Pediatric retinal photograph (wide-field): 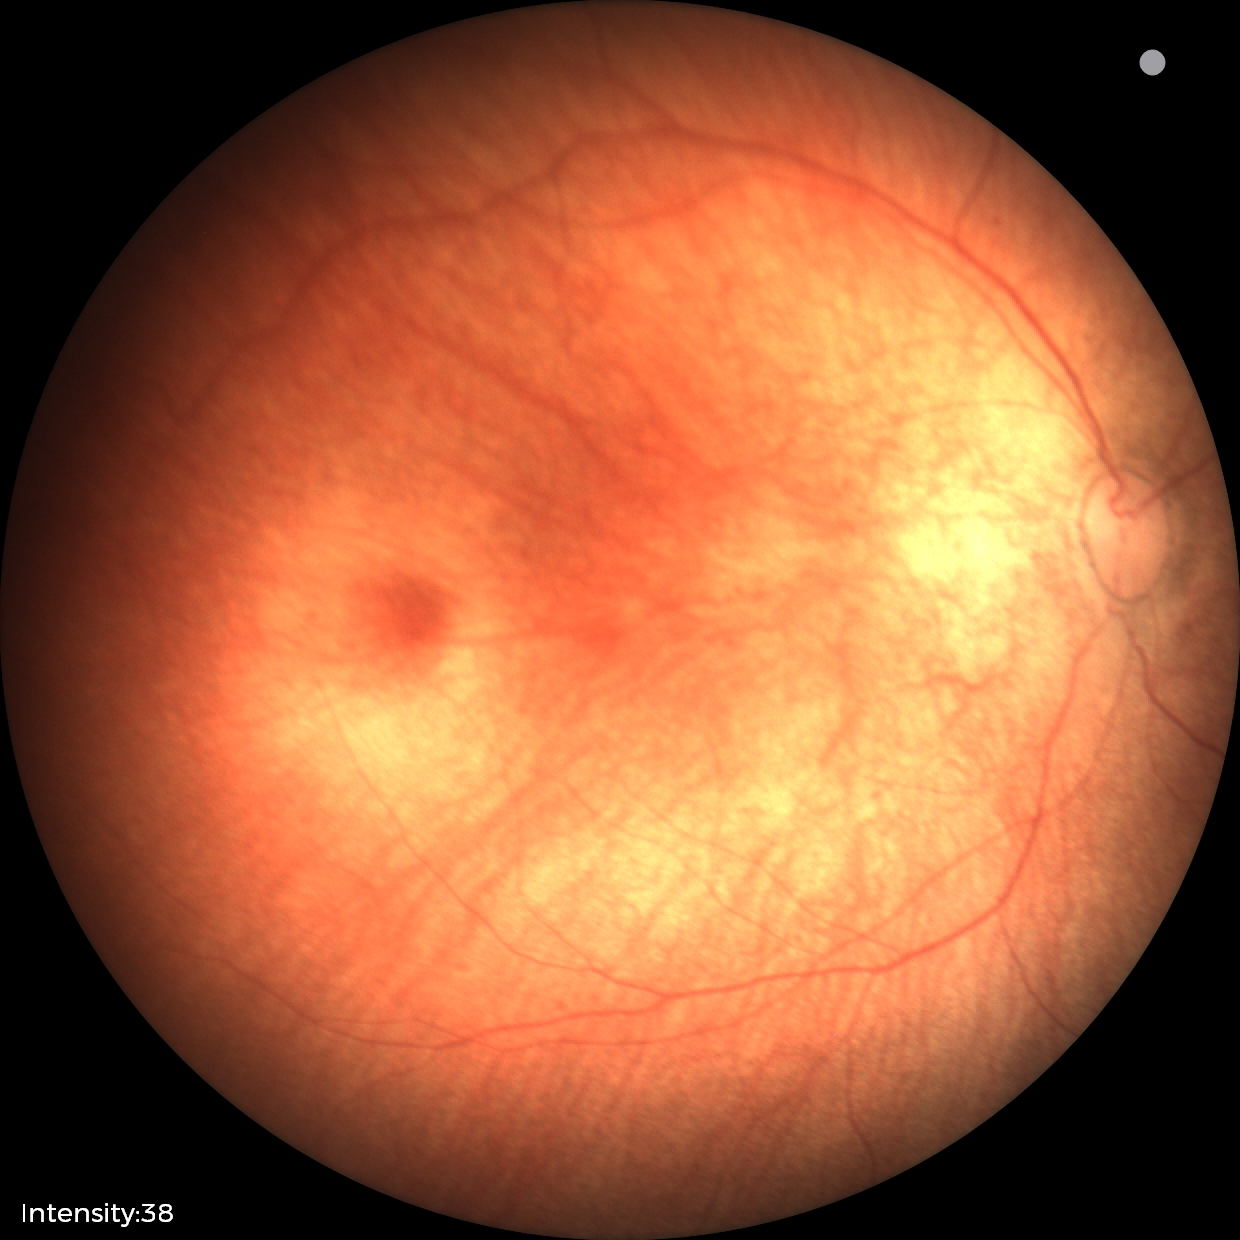
Screening examination diagnosed as physiological.